Infant wide-field retinal image
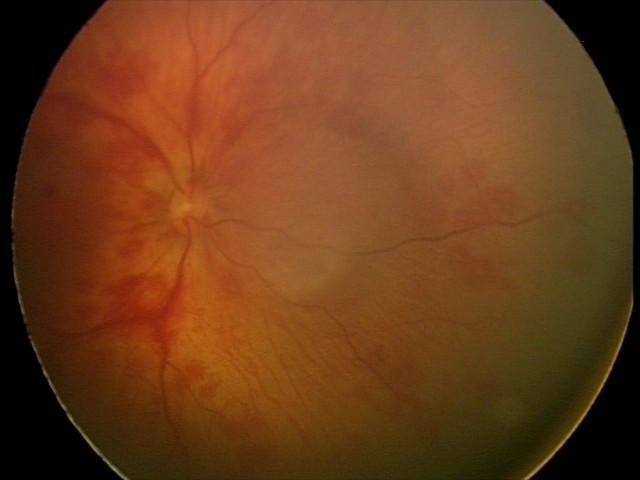

Screening examination consistent with retinal hemorrhages.